ONH-centered crop from a color fundus image — 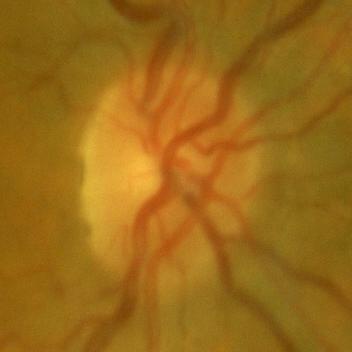 Findings consistent with no signs of glaucoma.